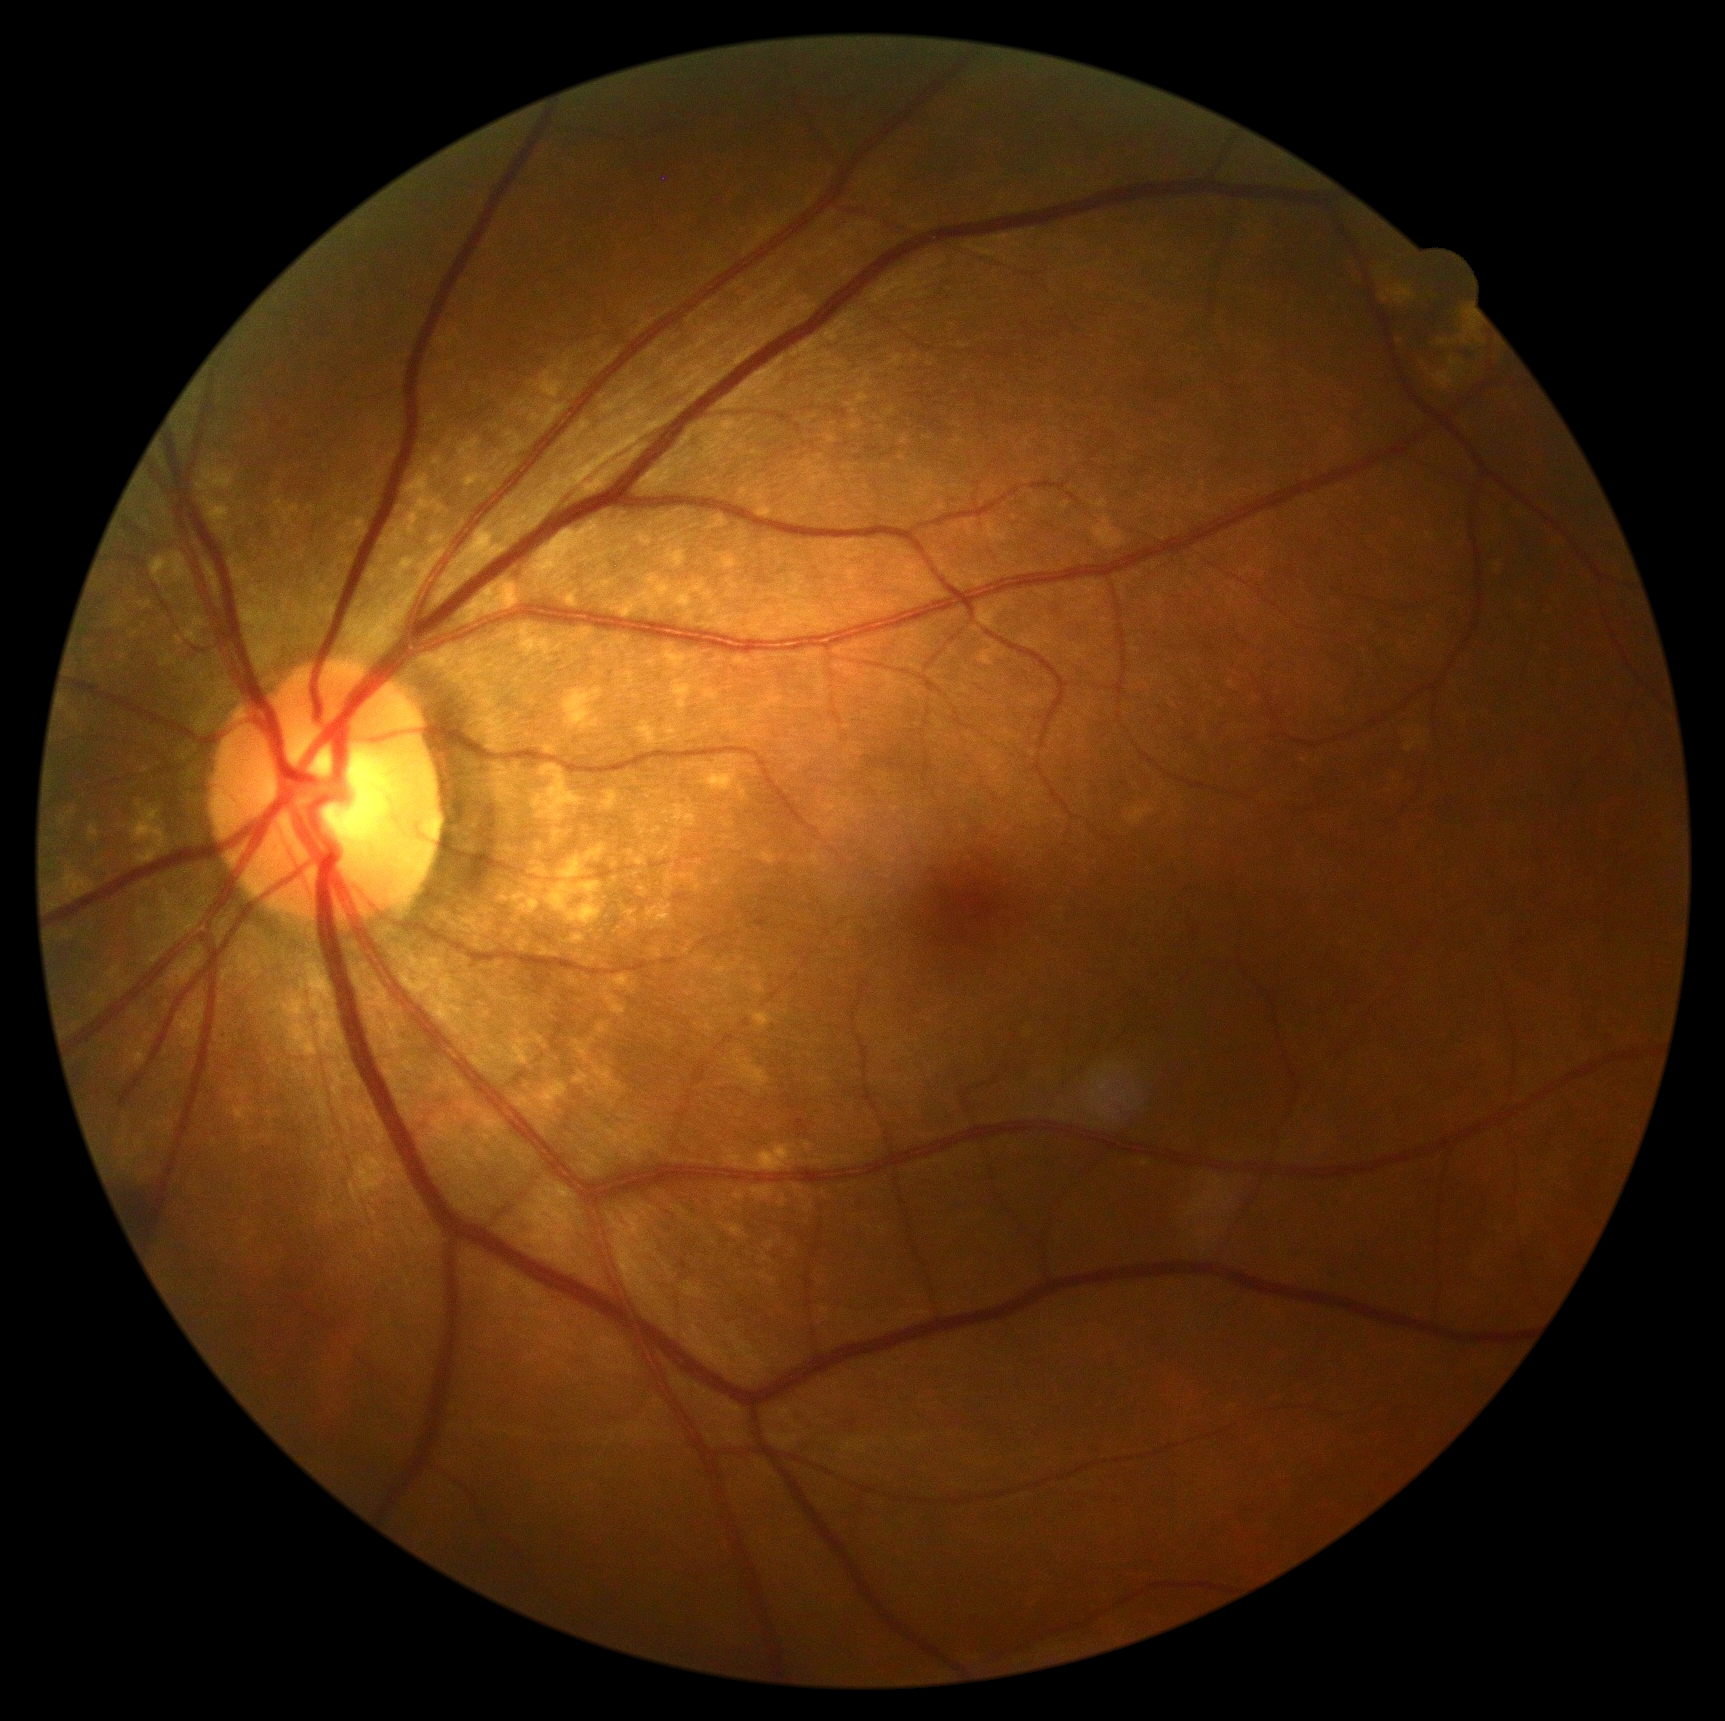
DR is 0. No diabetic retinal disease findings.